Image size 2048x1536; color fundus image
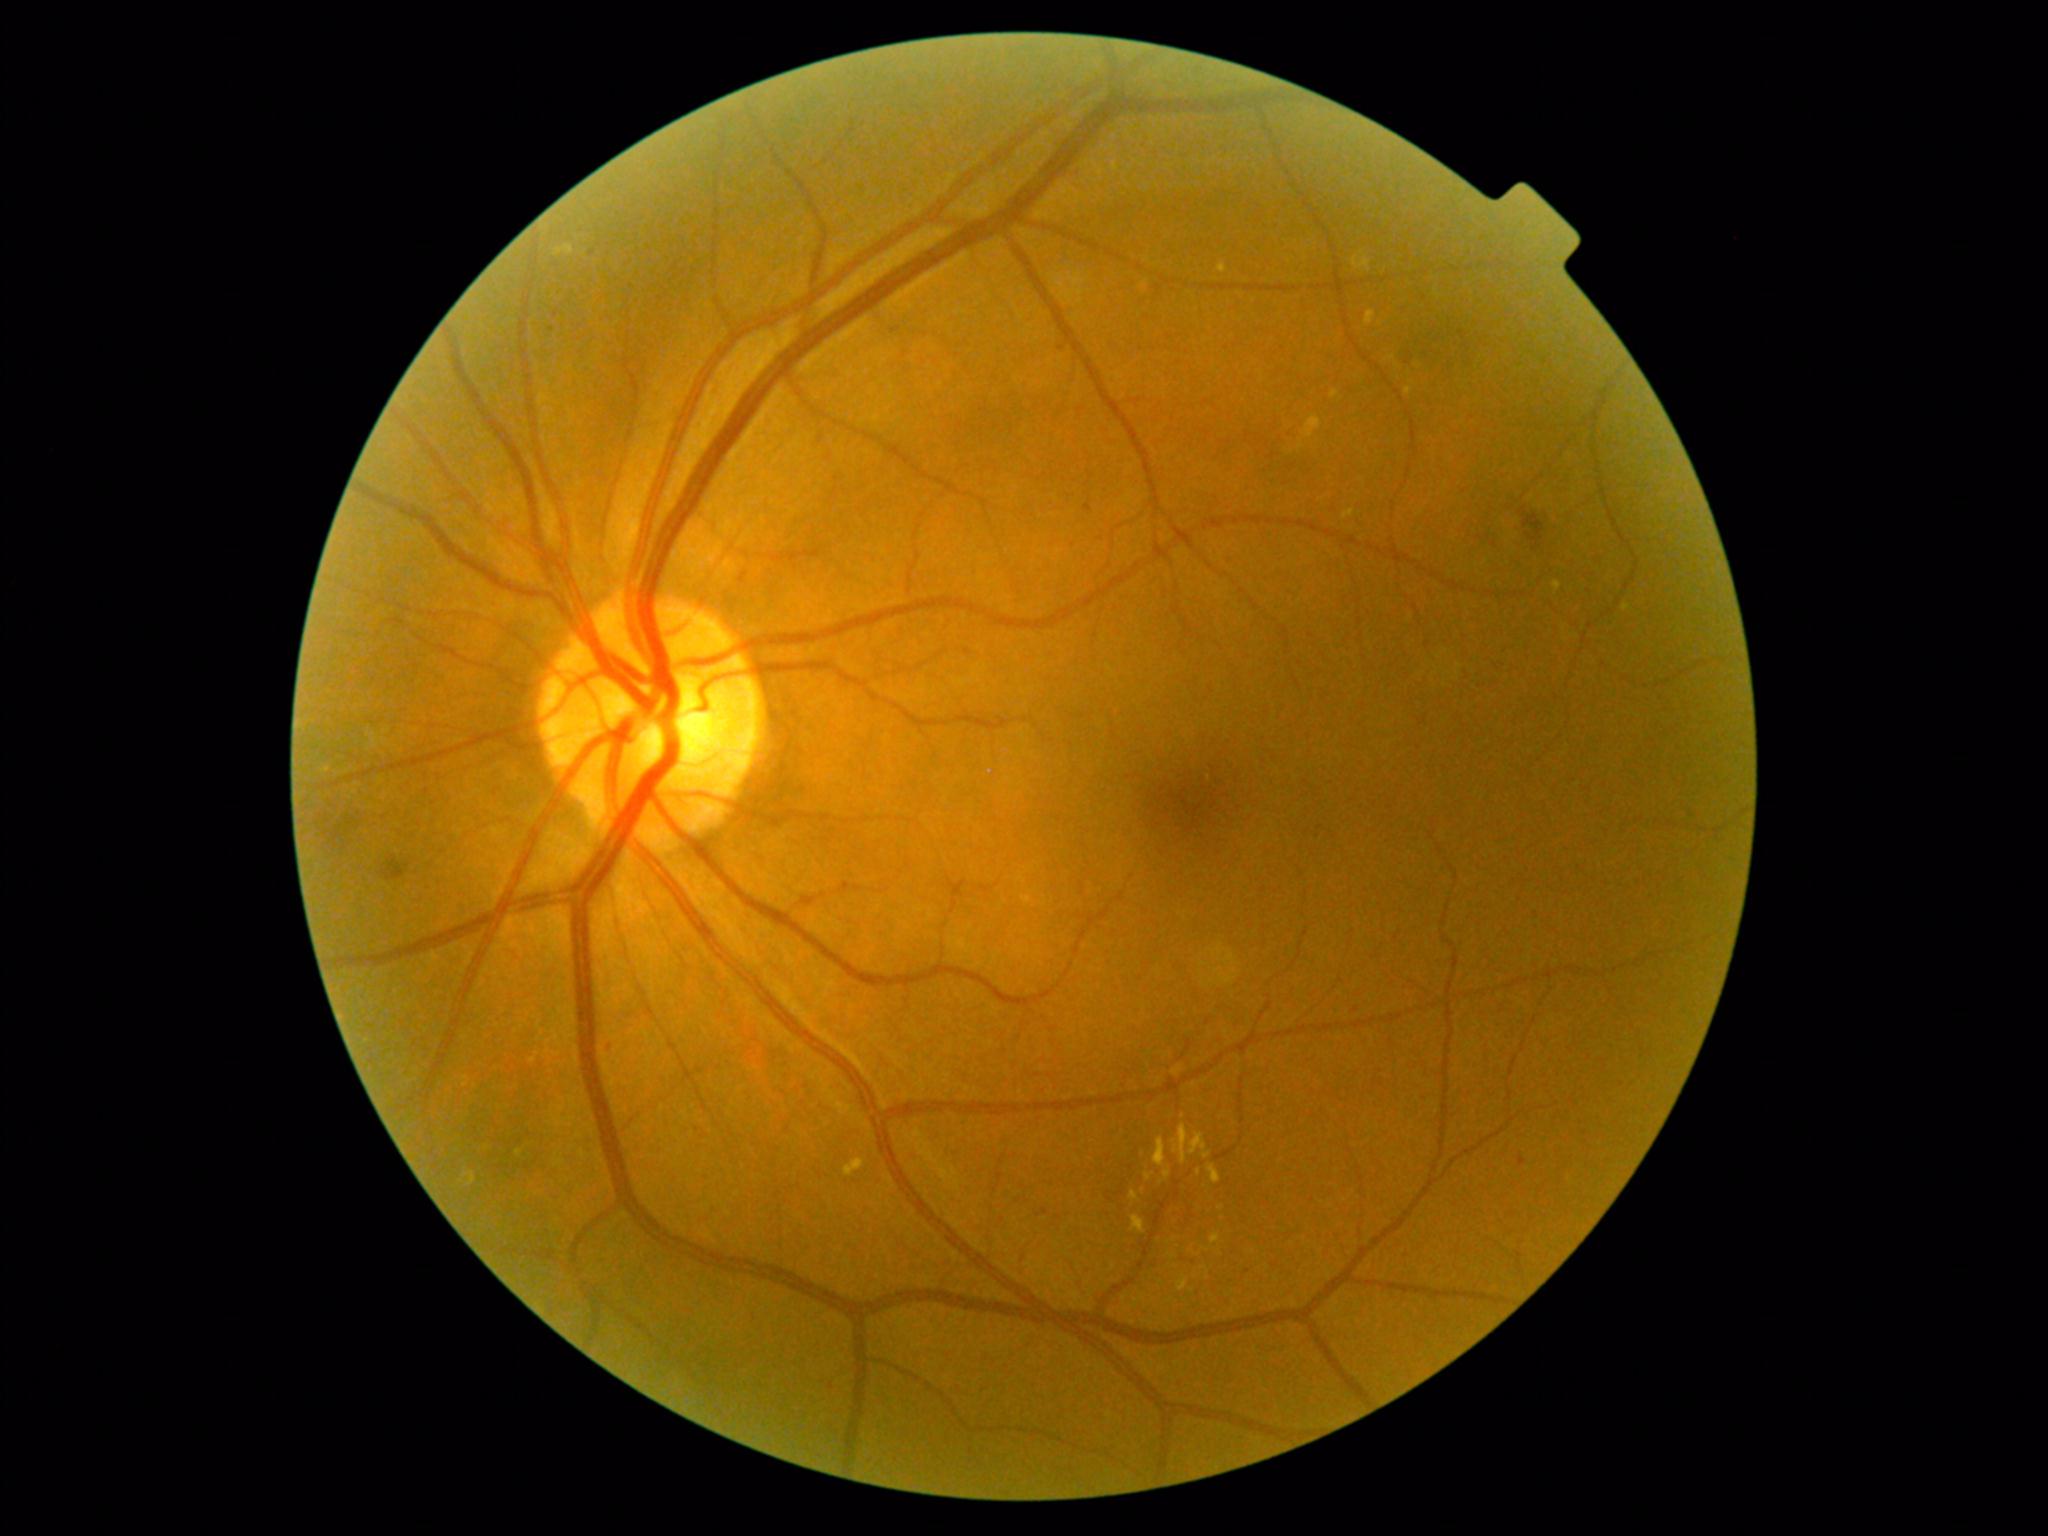
DR: 2
Lesions identified (partial list):
EXs (more not shown): Rect(1130, 1216, 1146, 1235), Rect(1622, 605, 1631, 611), Rect(1553, 581, 1562, 593), Rect(1163, 1169, 1172, 1180), Rect(1130, 1190, 1140, 1203), Rect(1343, 509, 1355, 521), Rect(1172, 1124, 1189, 1164), Rect(555, 245, 575, 257), Rect(1302, 416, 1321, 439), Rect(1178, 1275, 1189, 1292), Rect(845, 1158, 865, 1177), Rect(1145, 1173, 1153, 1181)
Small EXs near (1301; 447), (1143; 1192), (1174; 1240), (1192; 1291)
SEs: none
MAs: Rect(1084, 505, 1093, 512), Rect(605, 1040, 614, 1052), Rect(1519, 1156, 1526, 1167)
Small MAs near (552; 330), (592; 254), (1062; 348), (698; 1130), (1248; 1271), (556; 314)
HEs: Rect(1519, 506, 1545, 551), Rect(381, 856, 410, 882)